45° FOV. Image size 848x848. Posterior pole photograph. NIDEK AFC-230 fundus camera. No pharmacologic dilation — 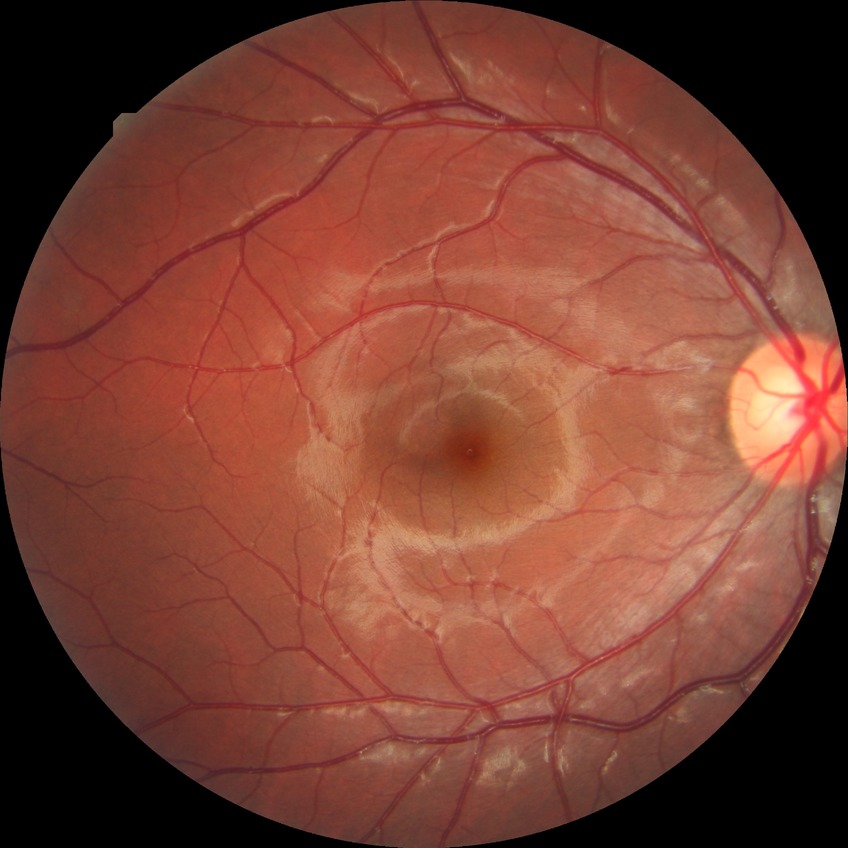

DR stage is NDR.